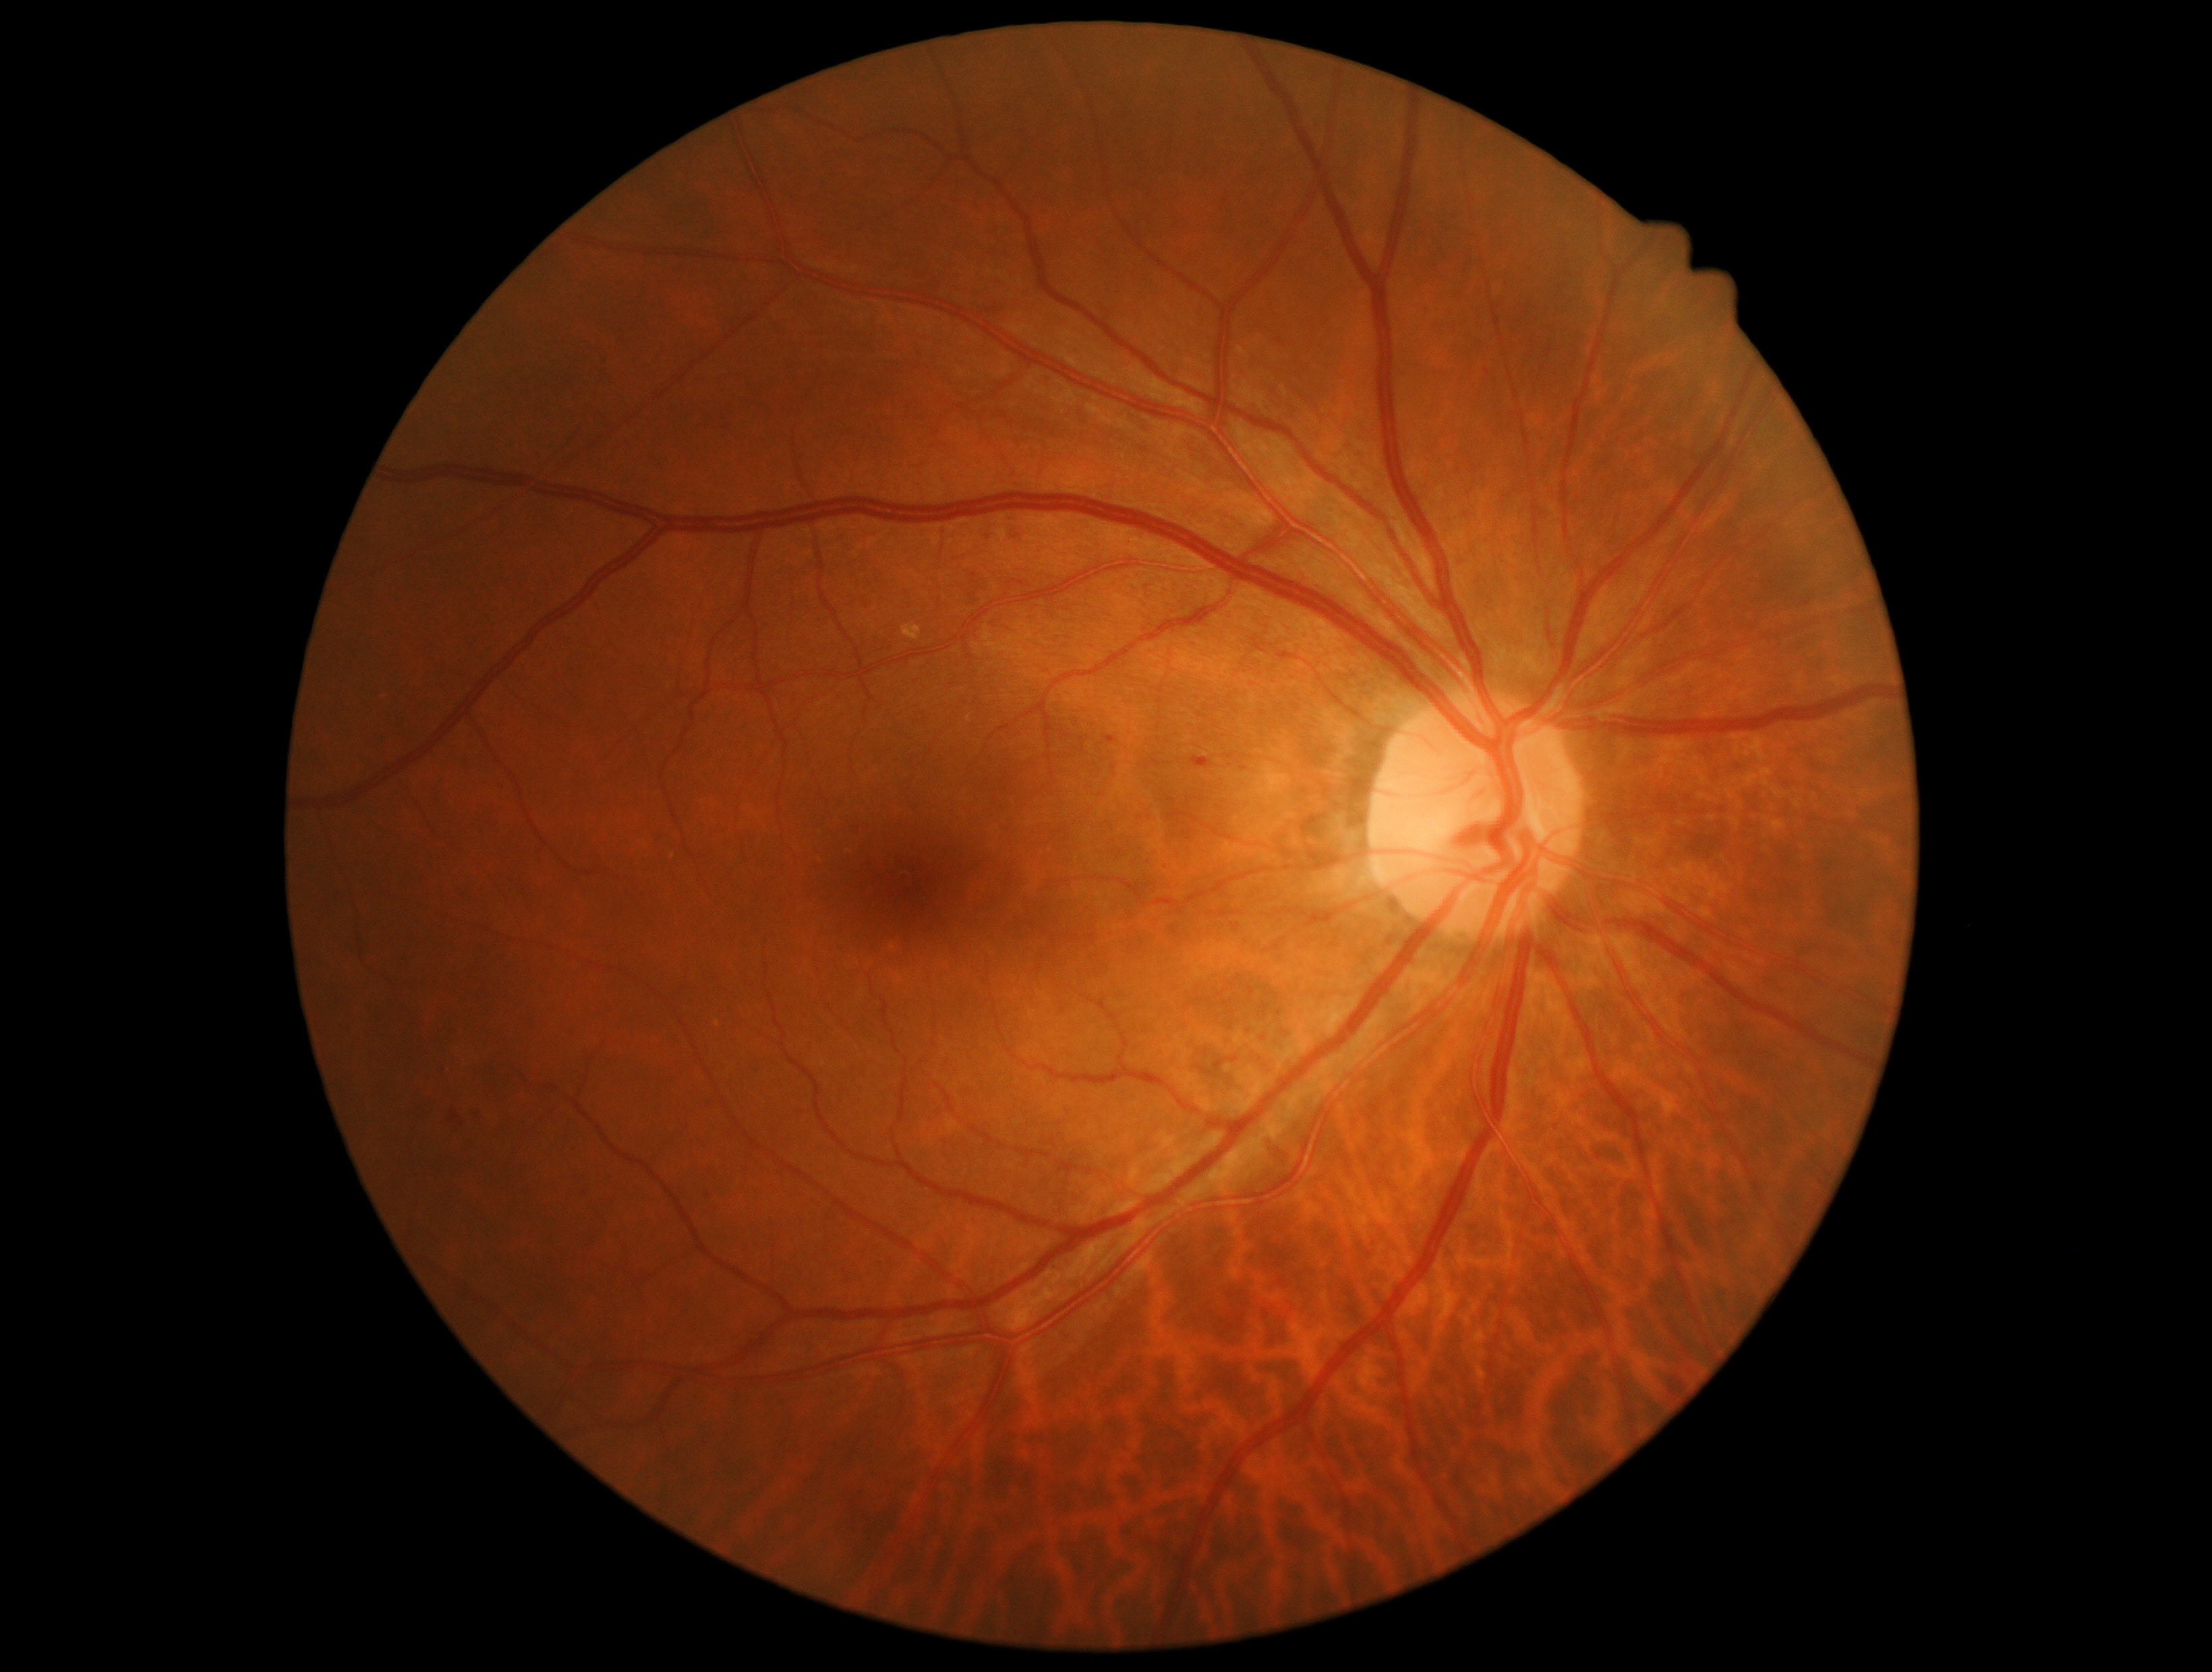 DR severity: moderate NPDR (grade 2).